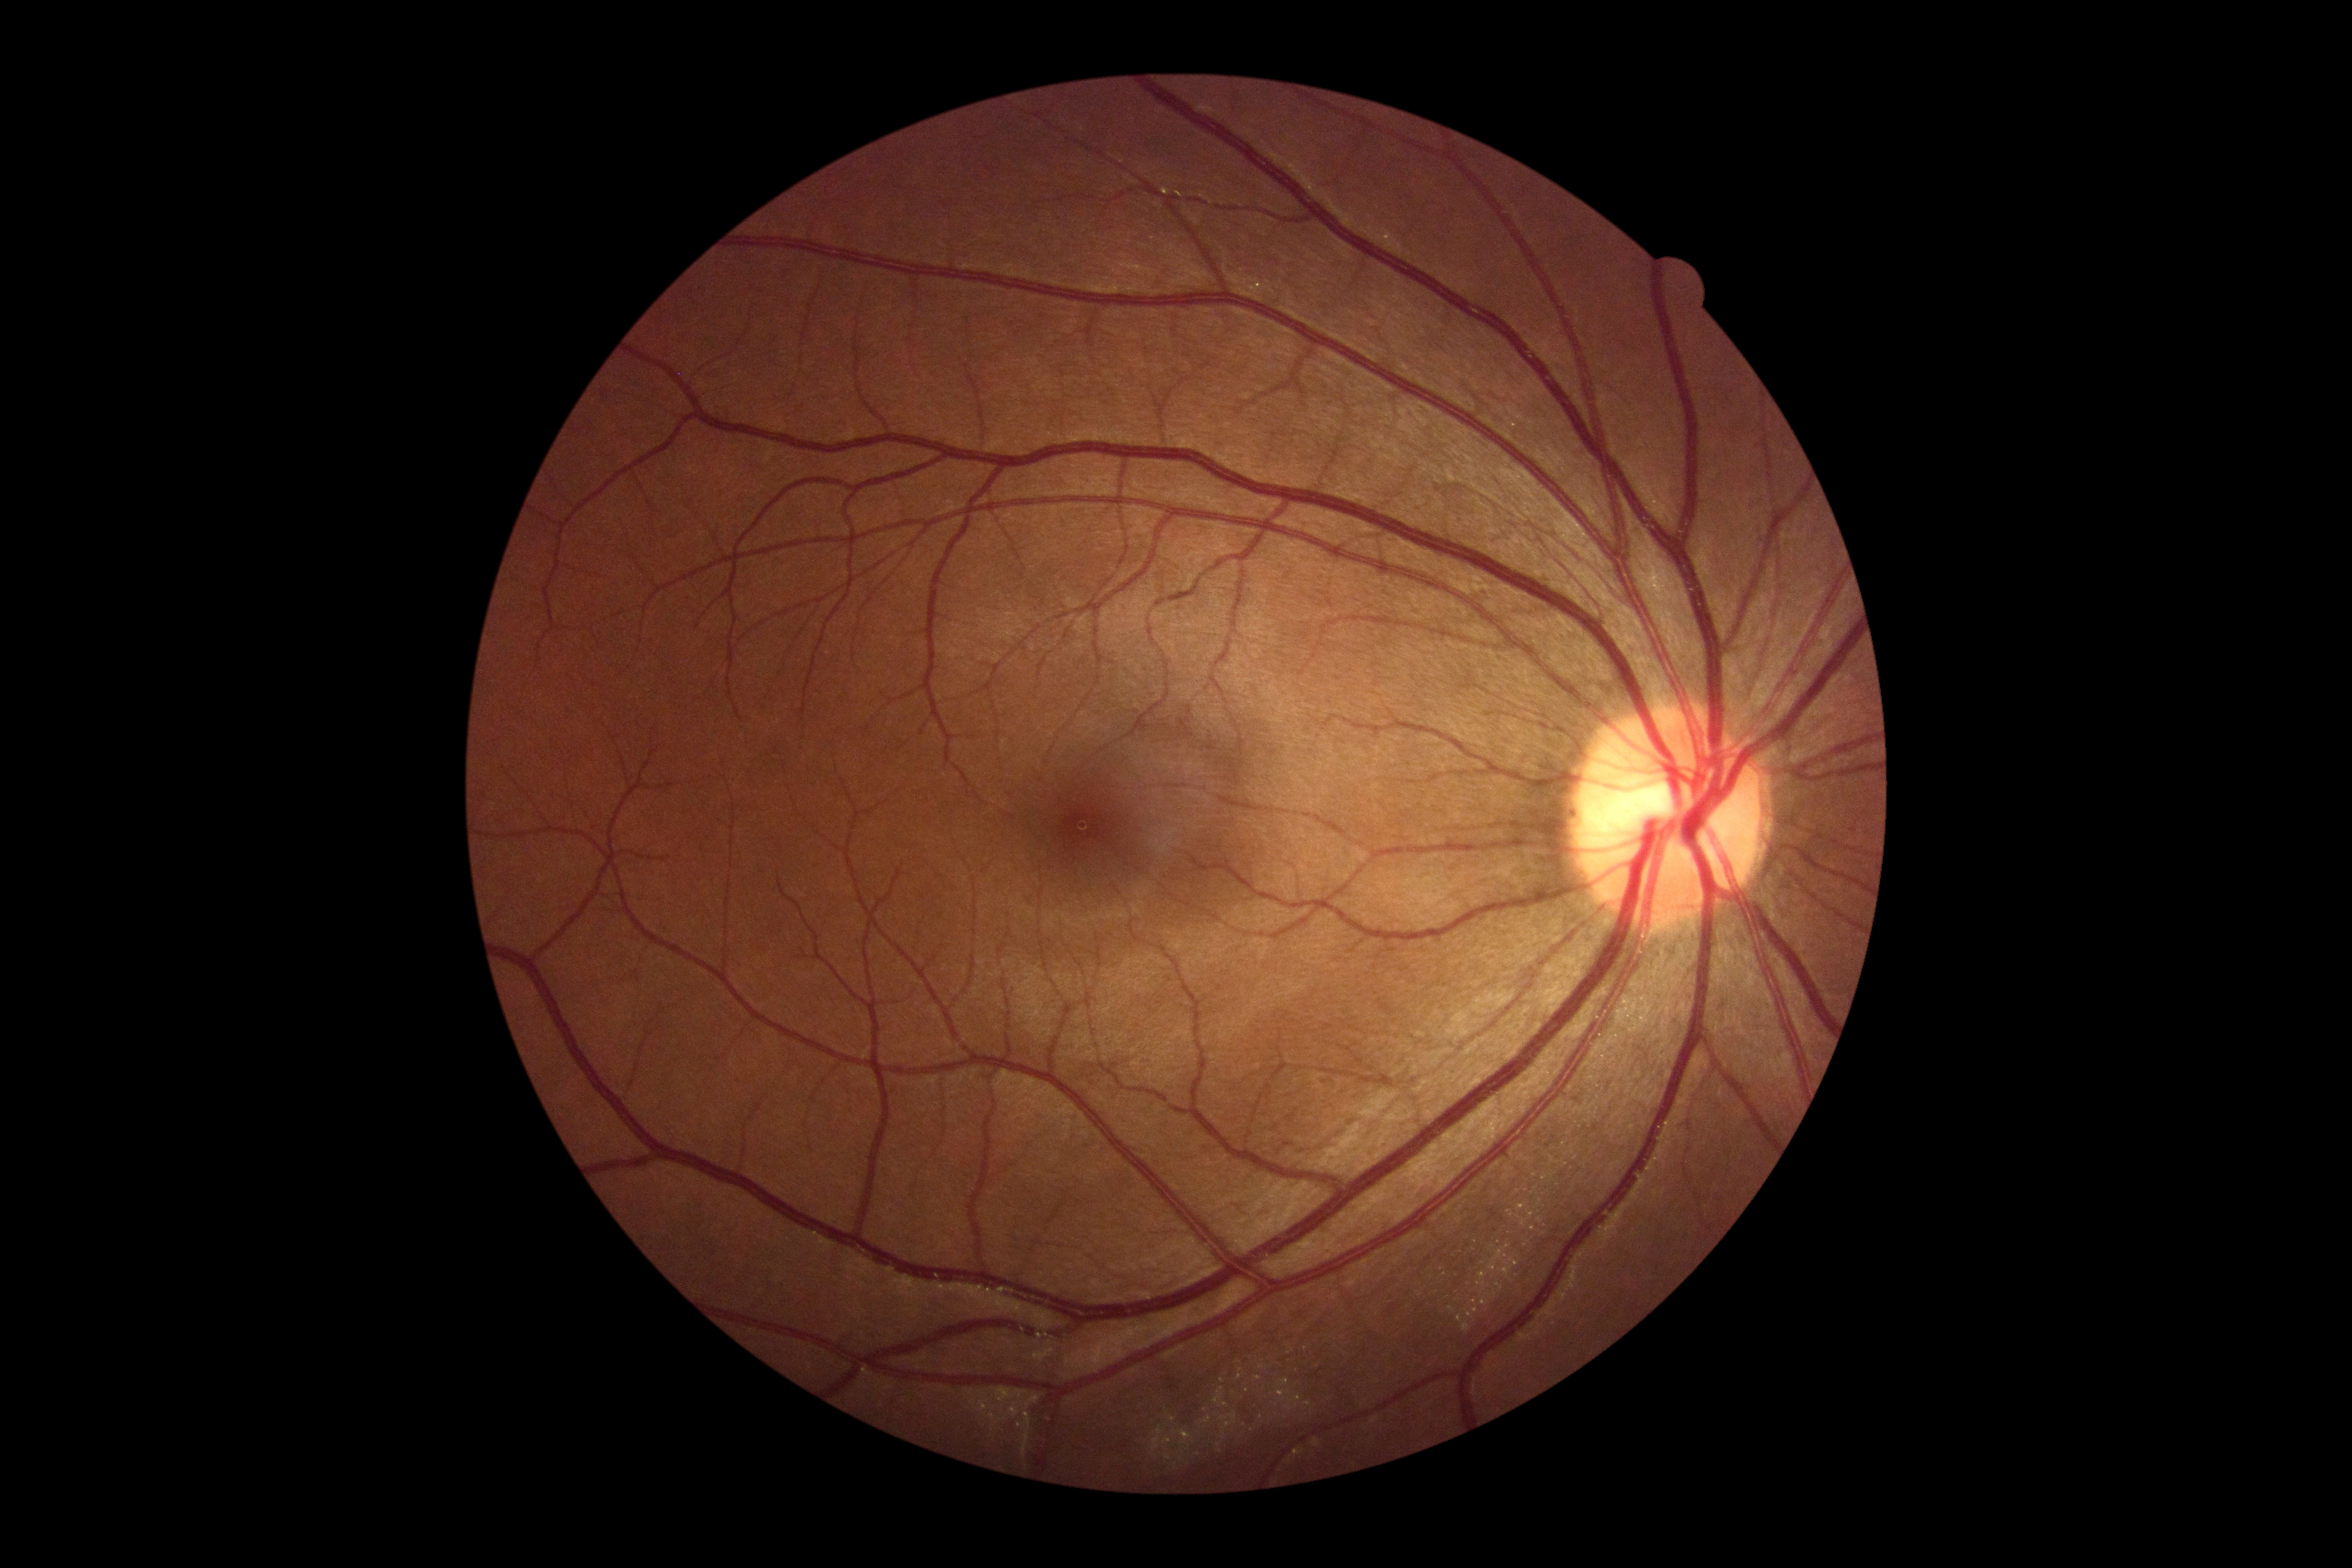
retinopathy: 0.